50° field of view. CFP. Camera: Topcon TRC-NW8:
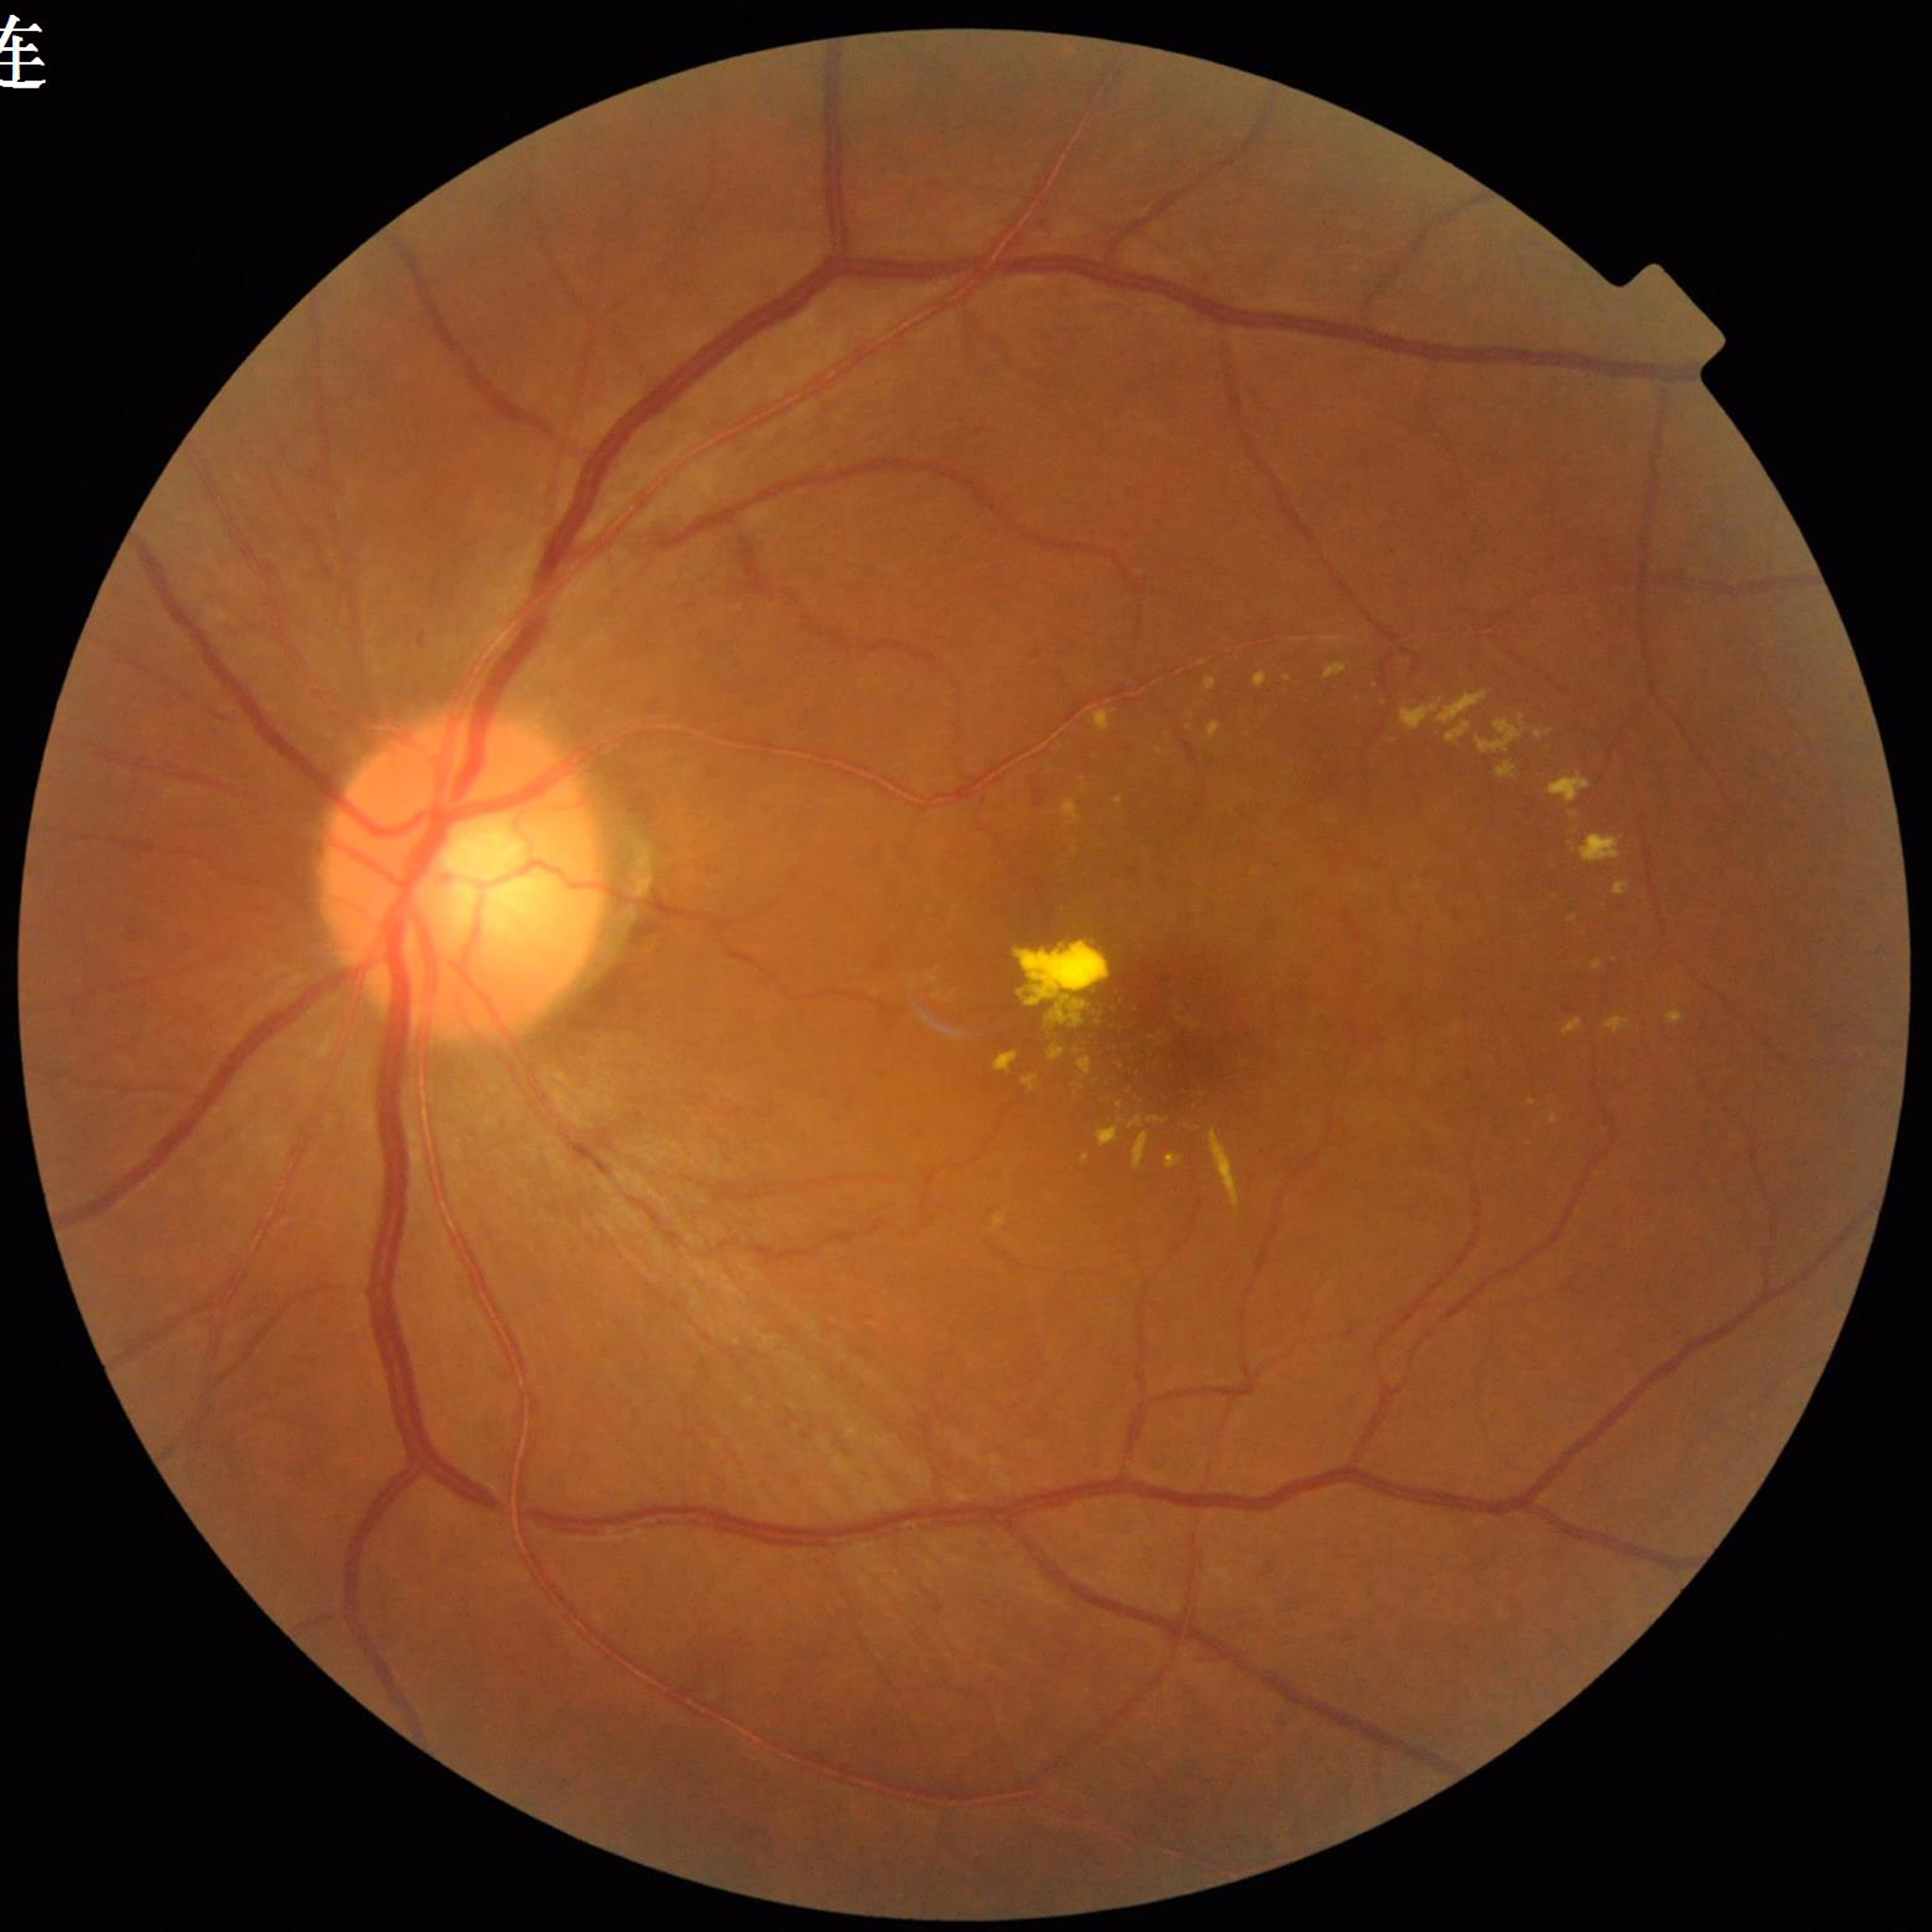
Patient diagnosed with age-related macular degeneration (AMD).